Wide-field fundus photograph from neonatal ROP screening.
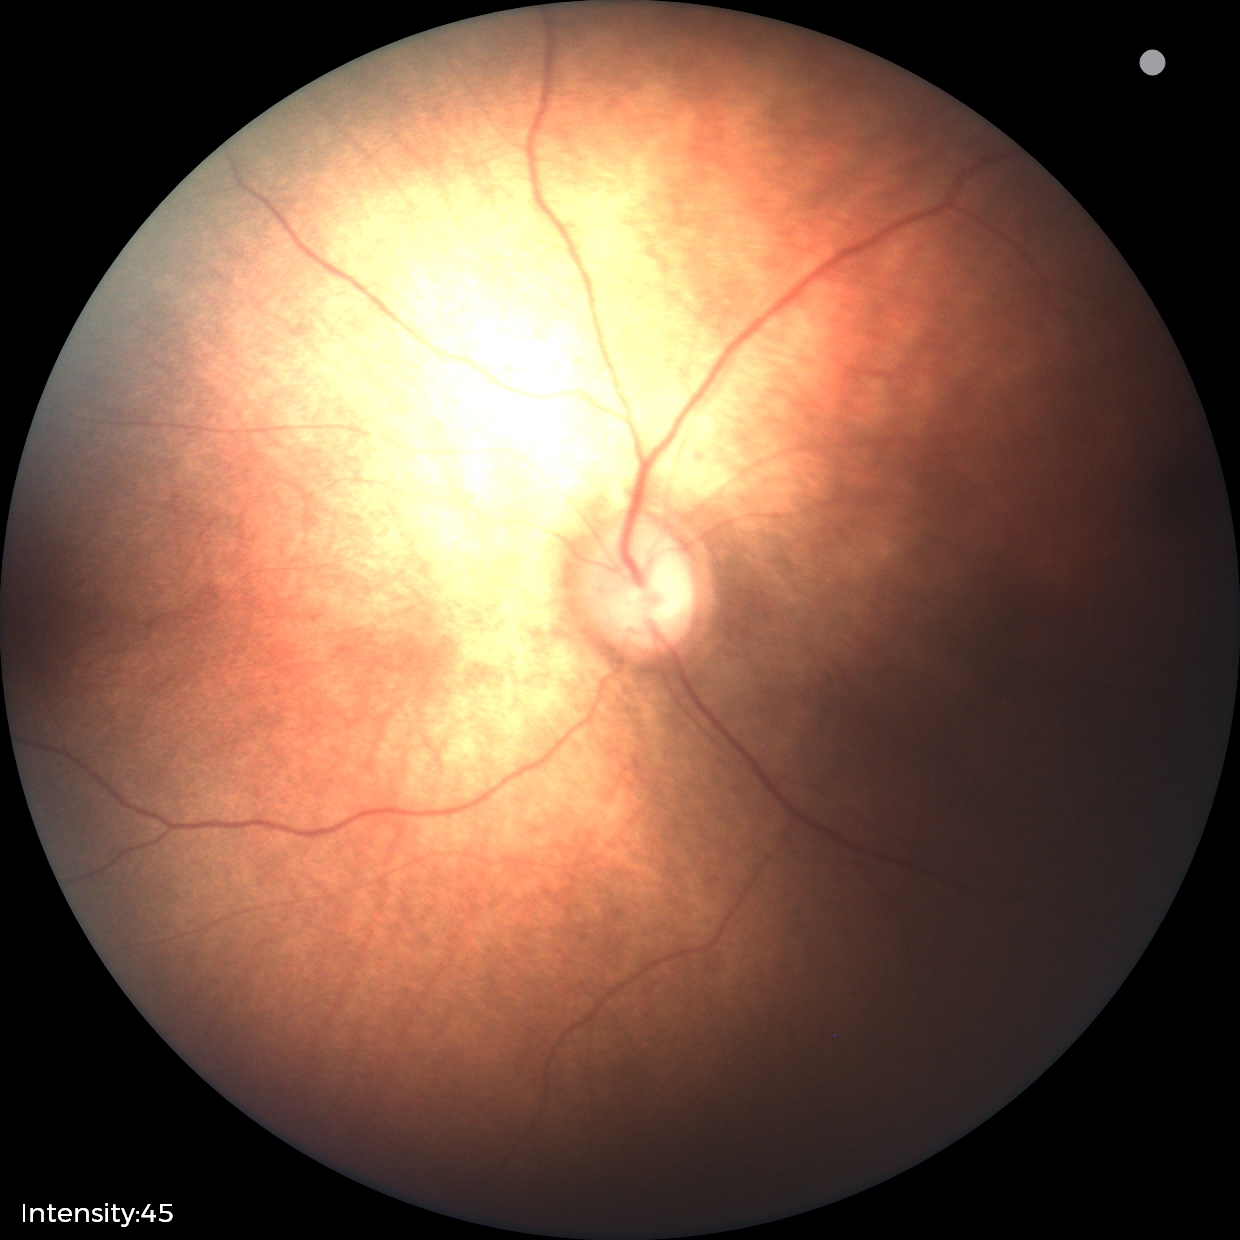 No retinal pathology identified on screening.